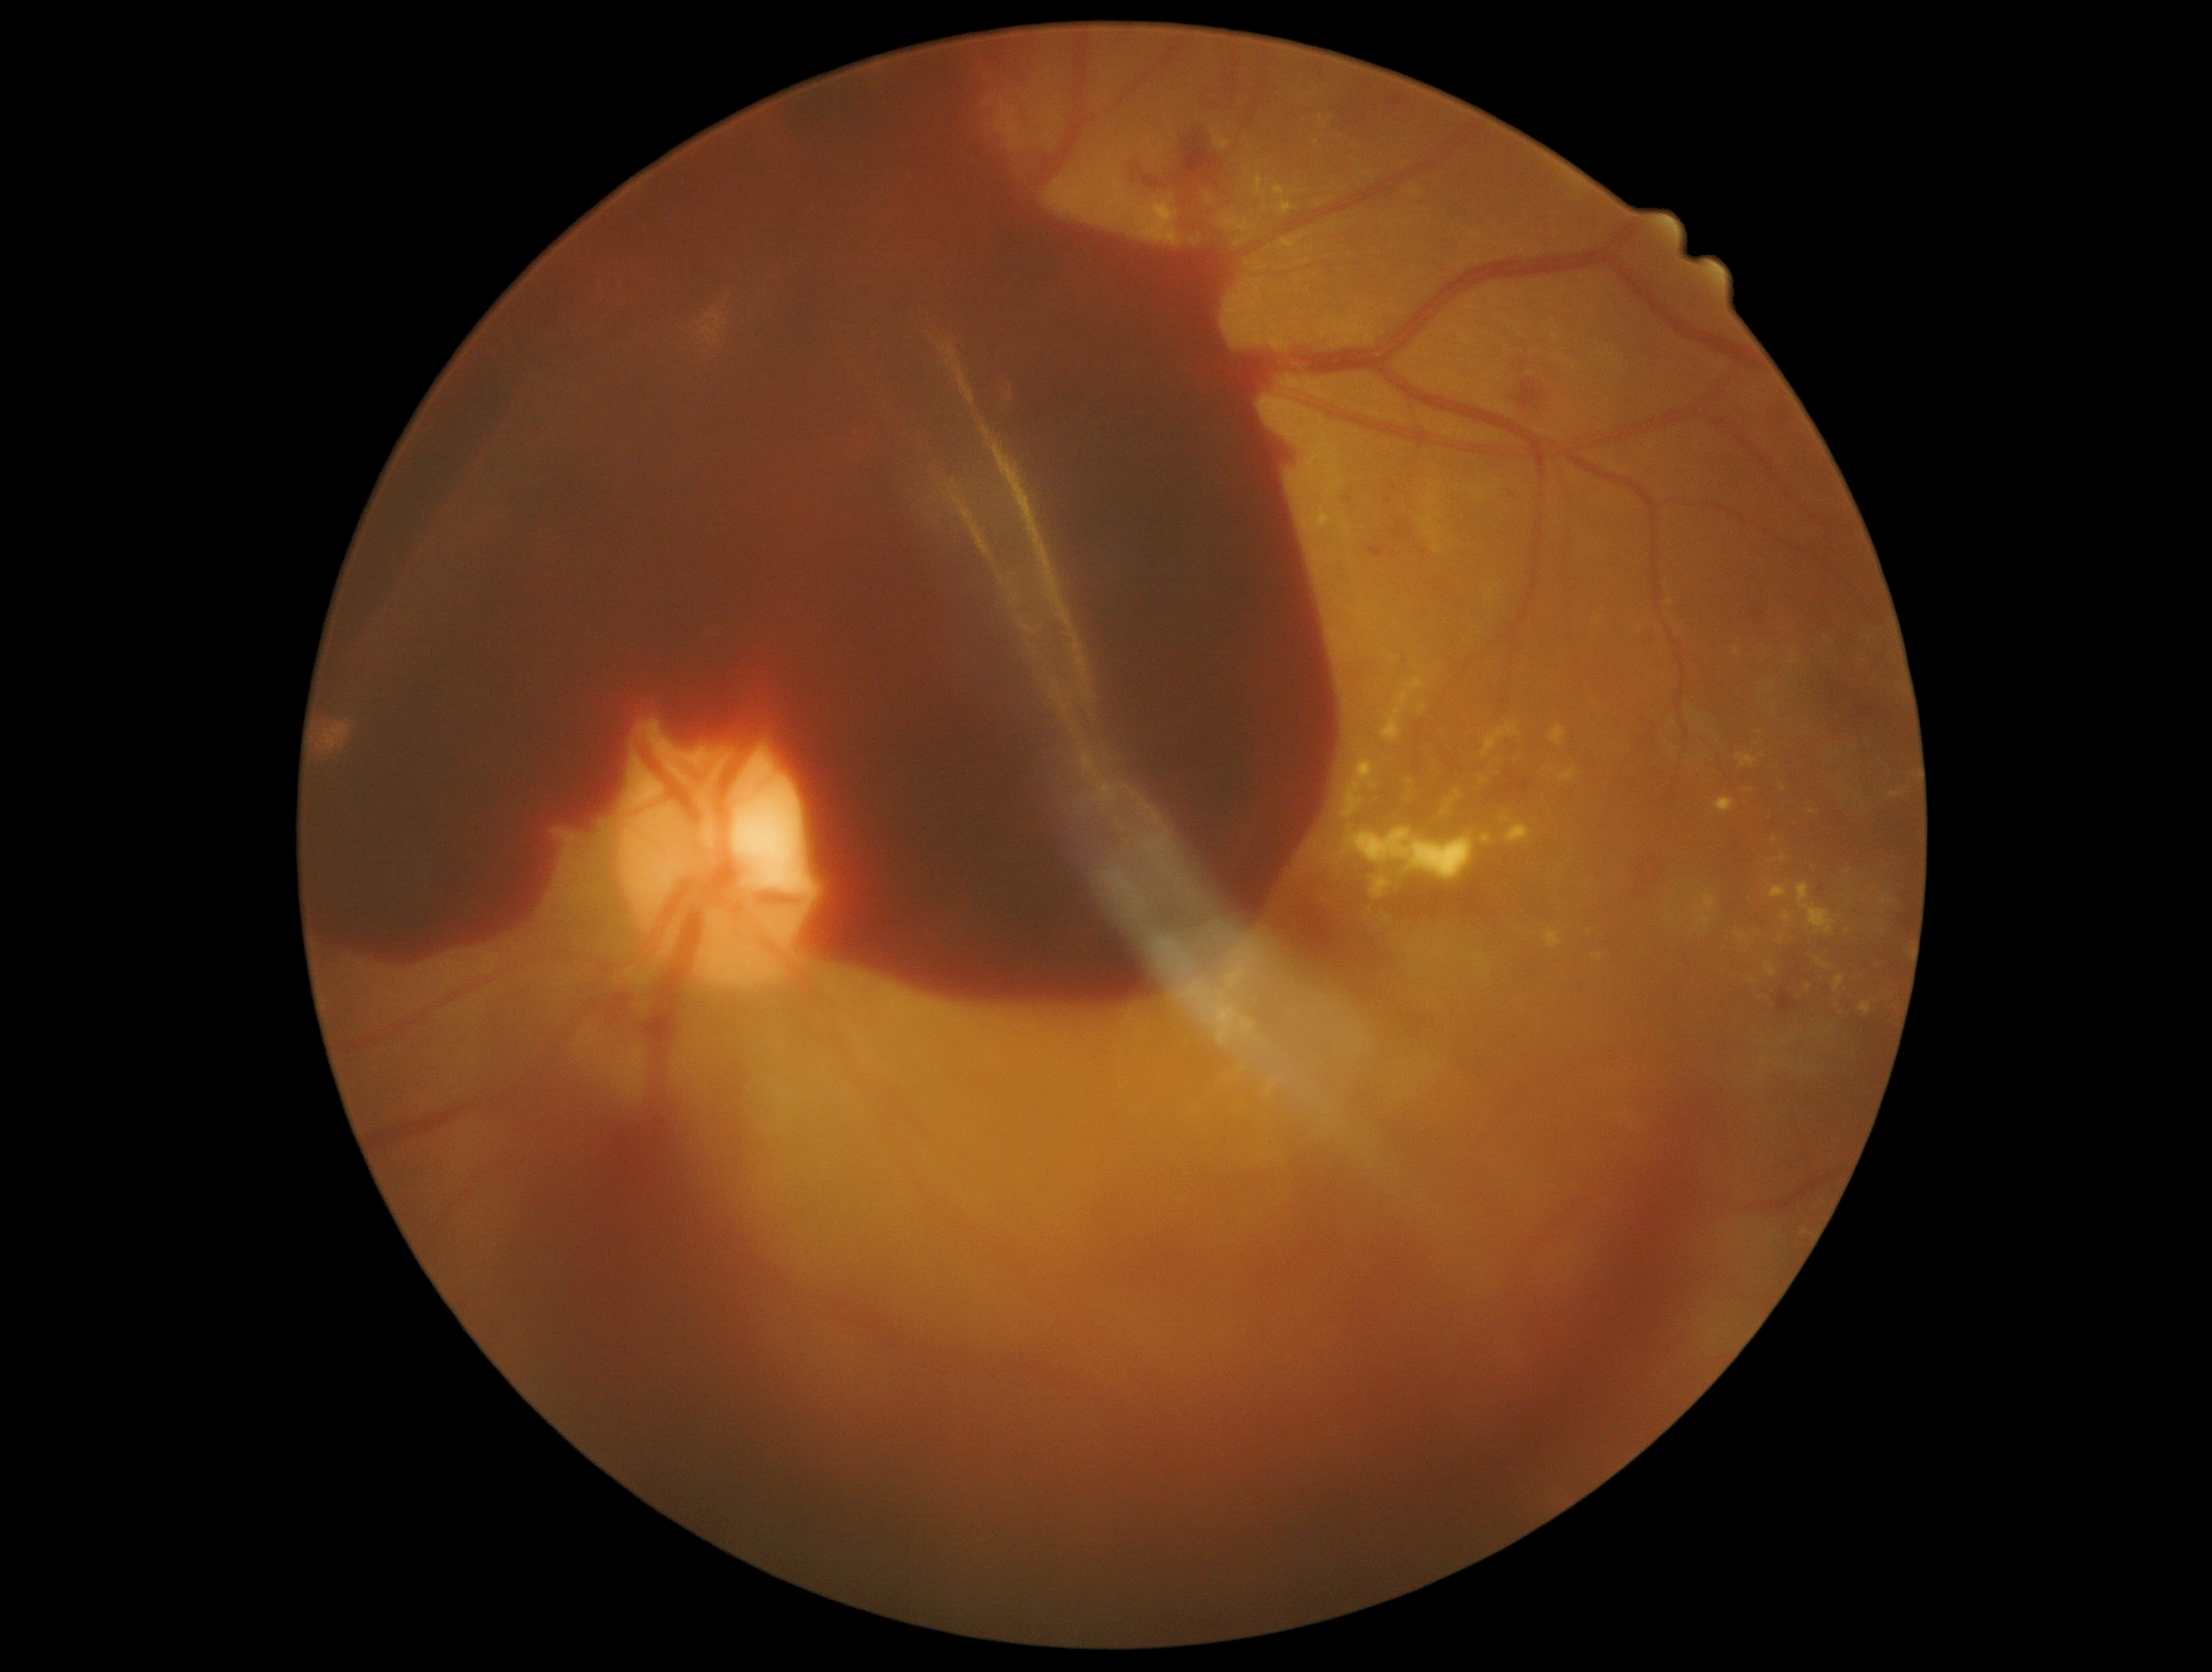
DR: 4/4.